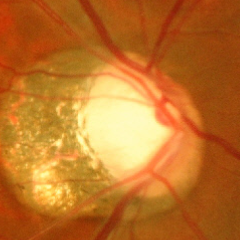 Glaucoma assessment: advanced-stage glaucoma.